Image size 1240x1240; wide-field fundus photograph from neonatal ROP screening: 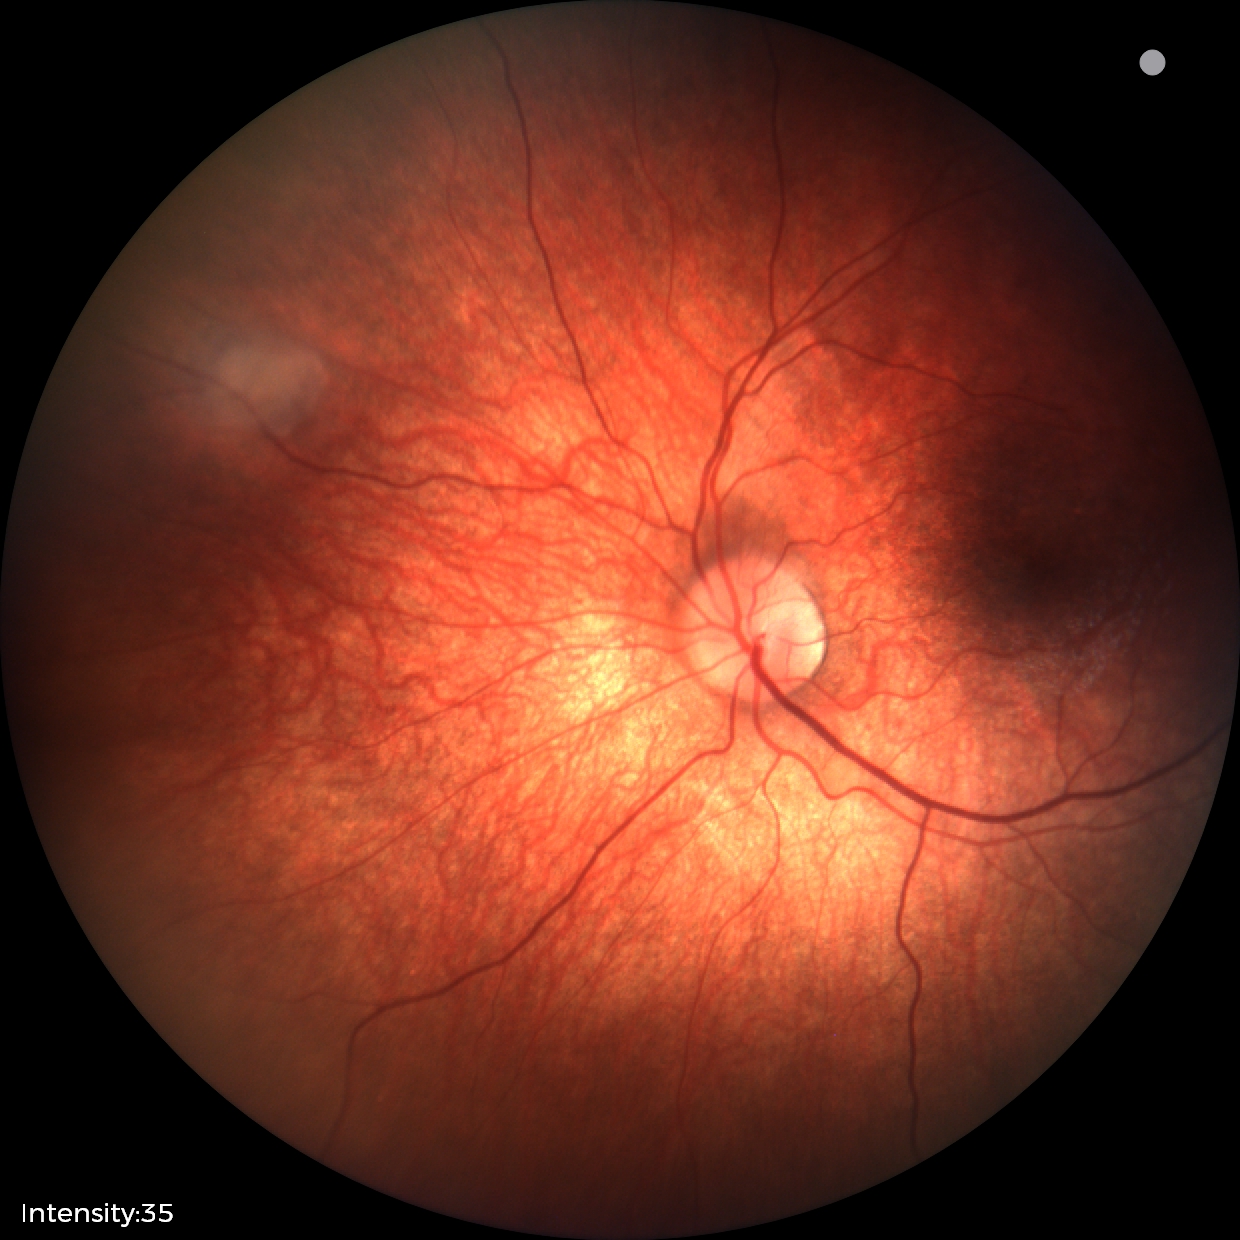
Examination diagnosed as retinal astrocytic hamartoma.